Pediatric retinal photograph (wide-field); camera: Phoenix ICON (100° FOV); 1240x1240px — 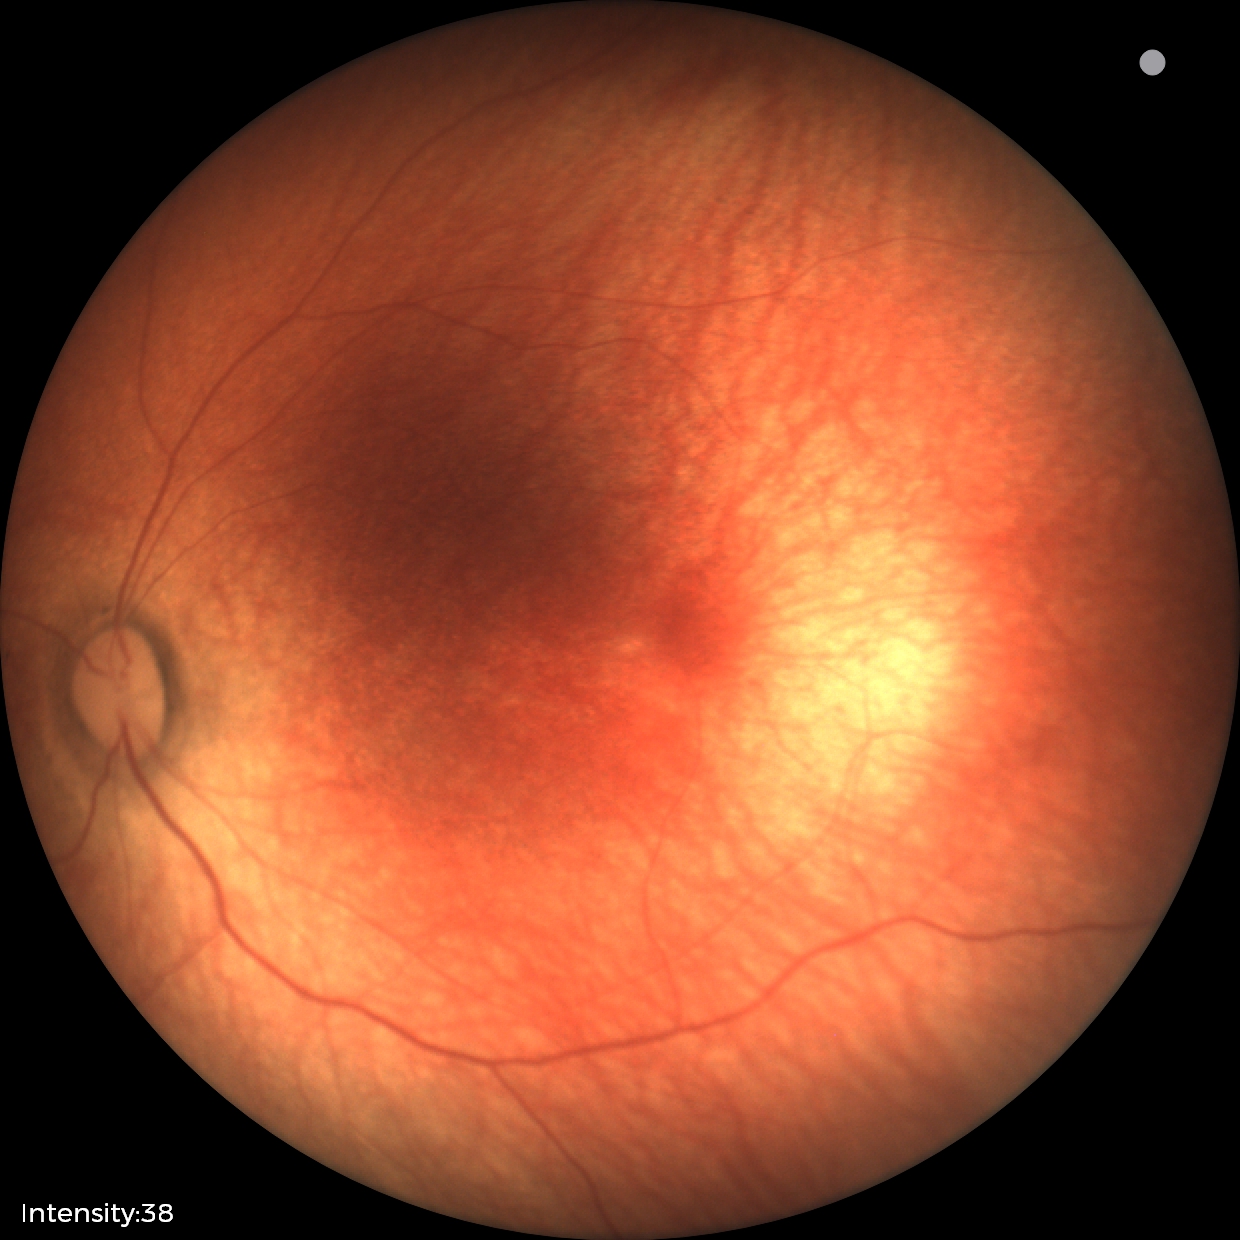
Finding: normal retinal appearance.